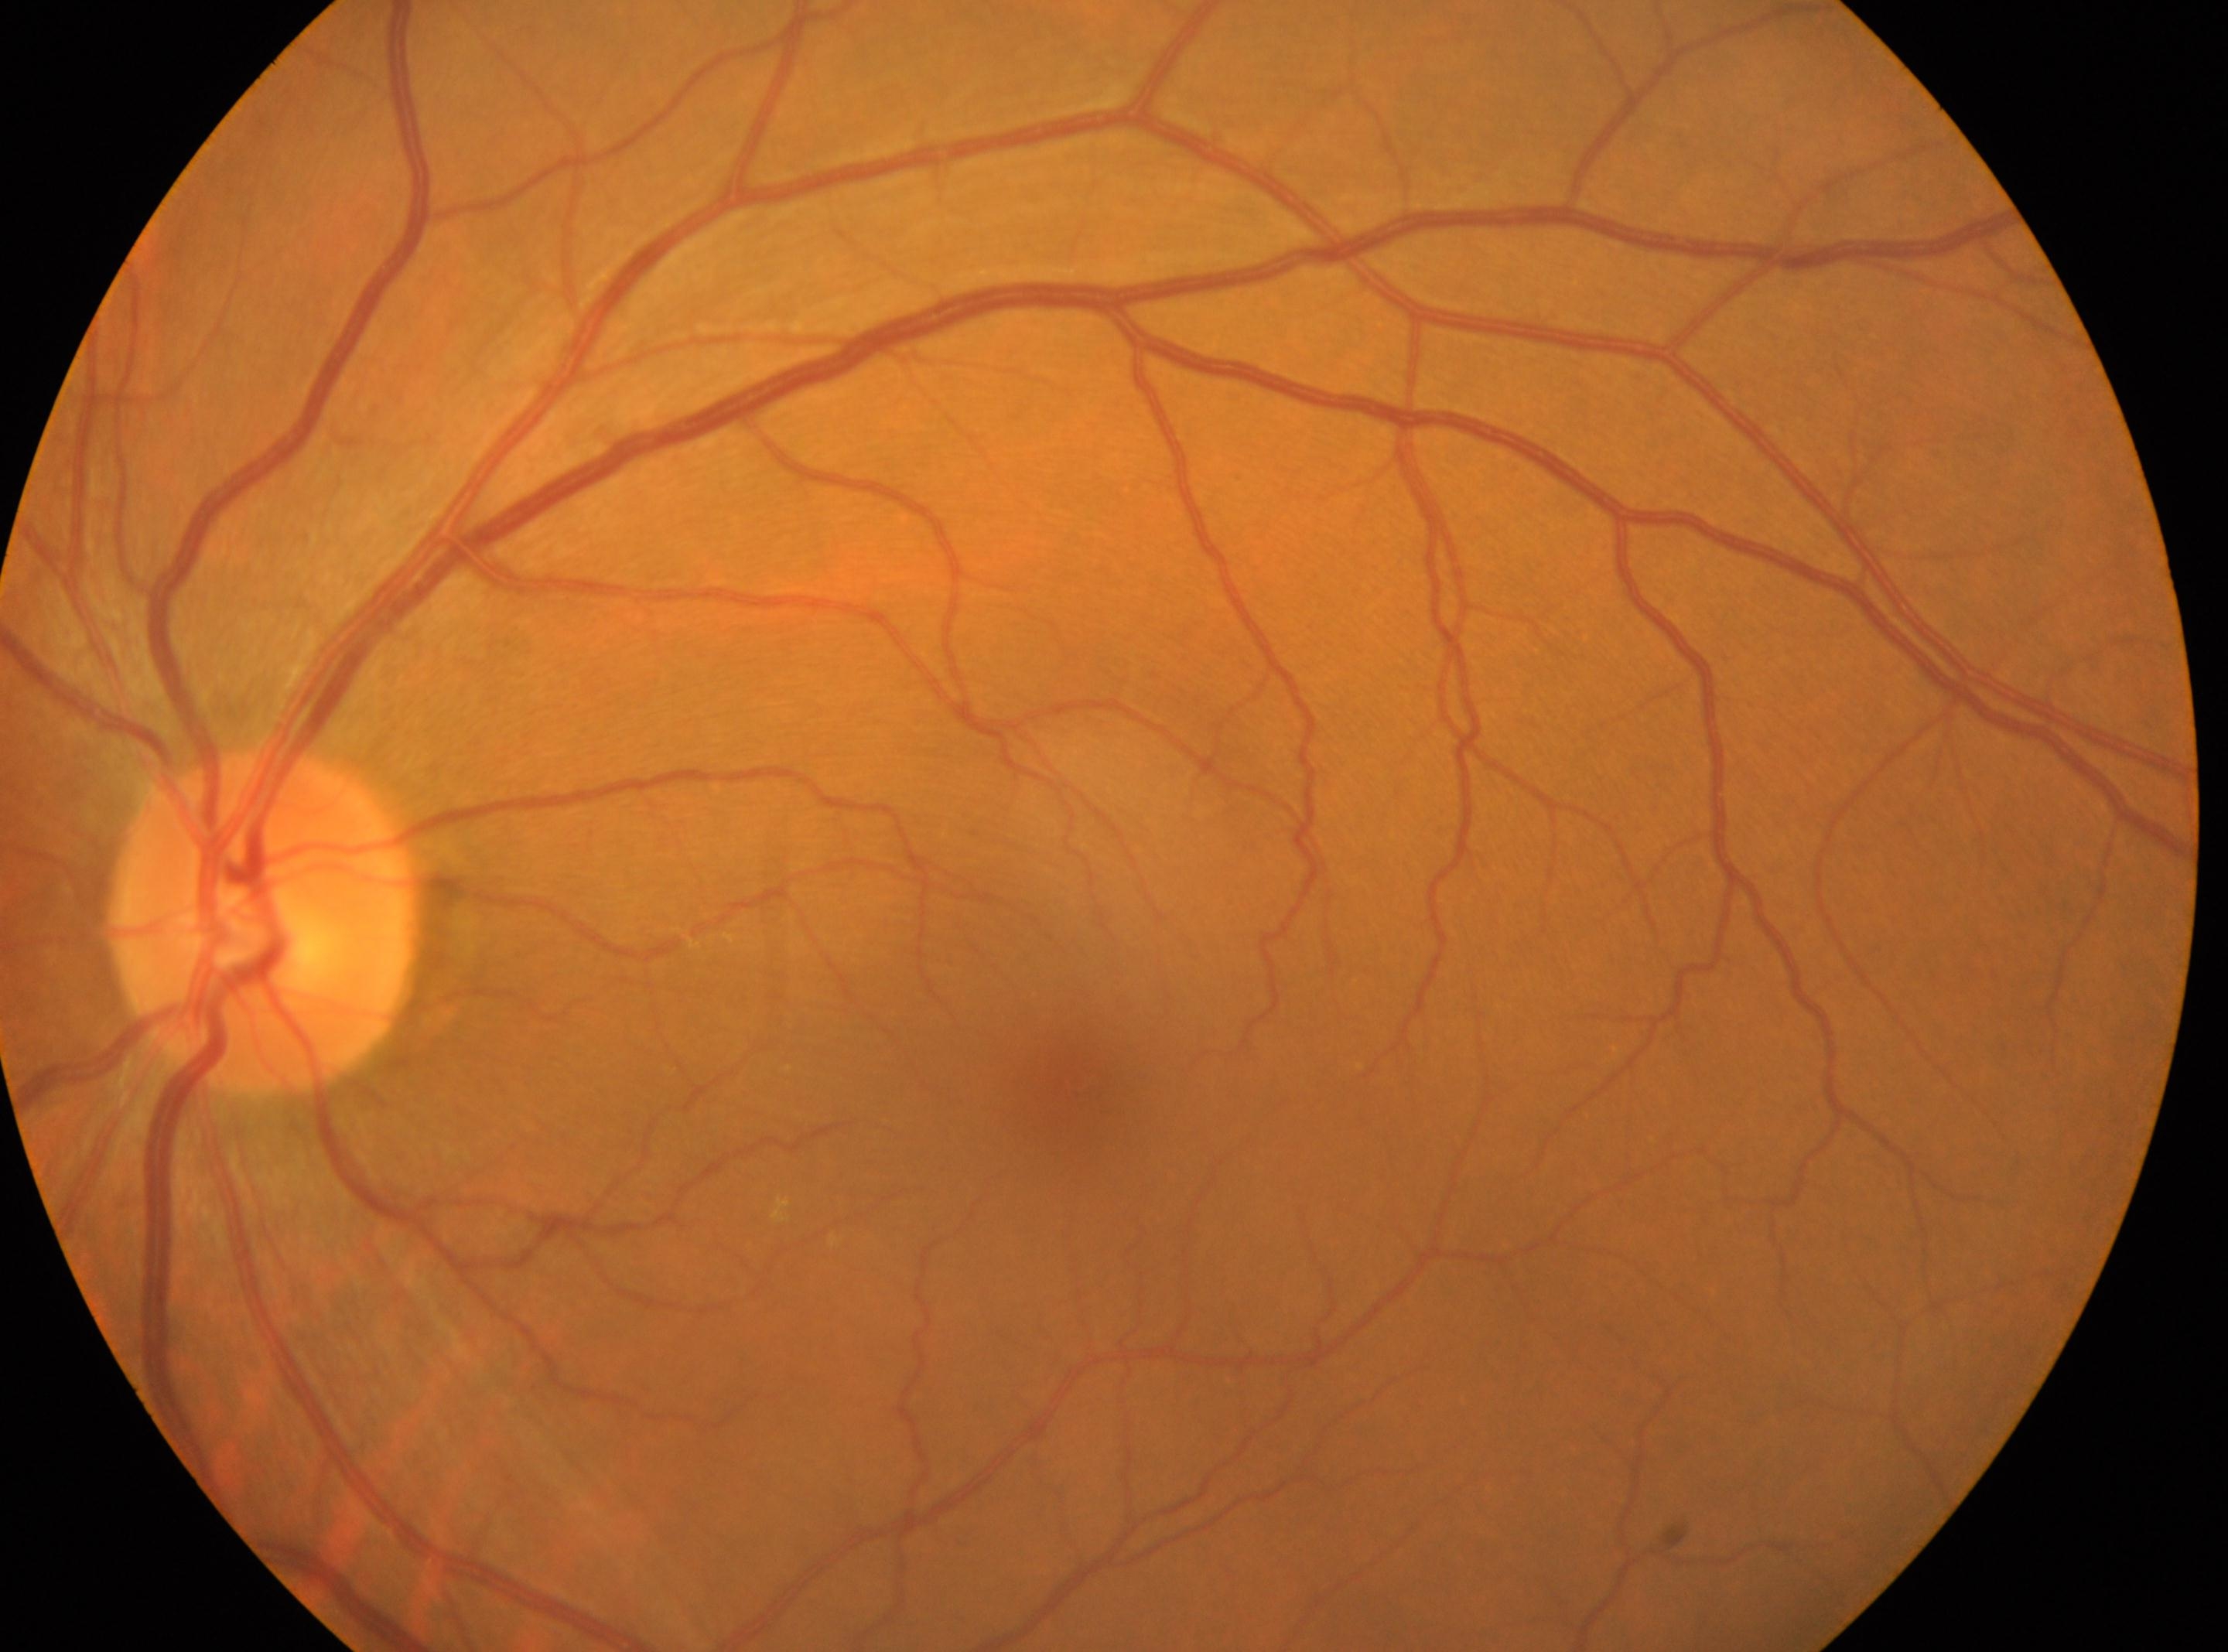
The ONH is at (266,923).
DR severity is grade 0 (no apparent retinopathy).
Macula center located at (1058,1087).
Imaged eye: the left eye.
No diabetic retinal disease findings.